640x480px · wide-field fundus image from infant ROP screening: 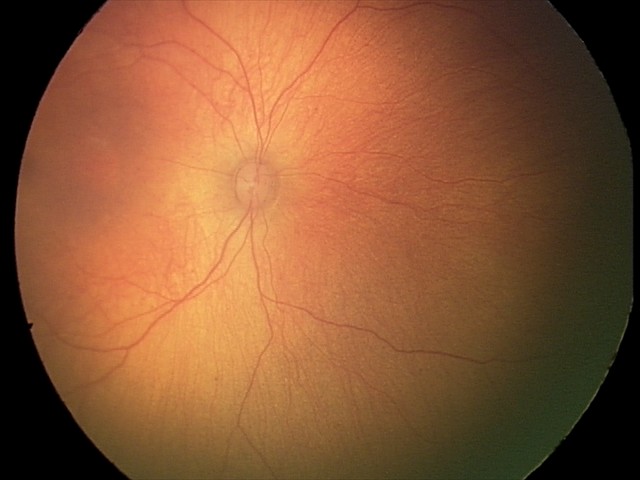

Physiological retinal appearance for postconceptual age.